1932x1923px:
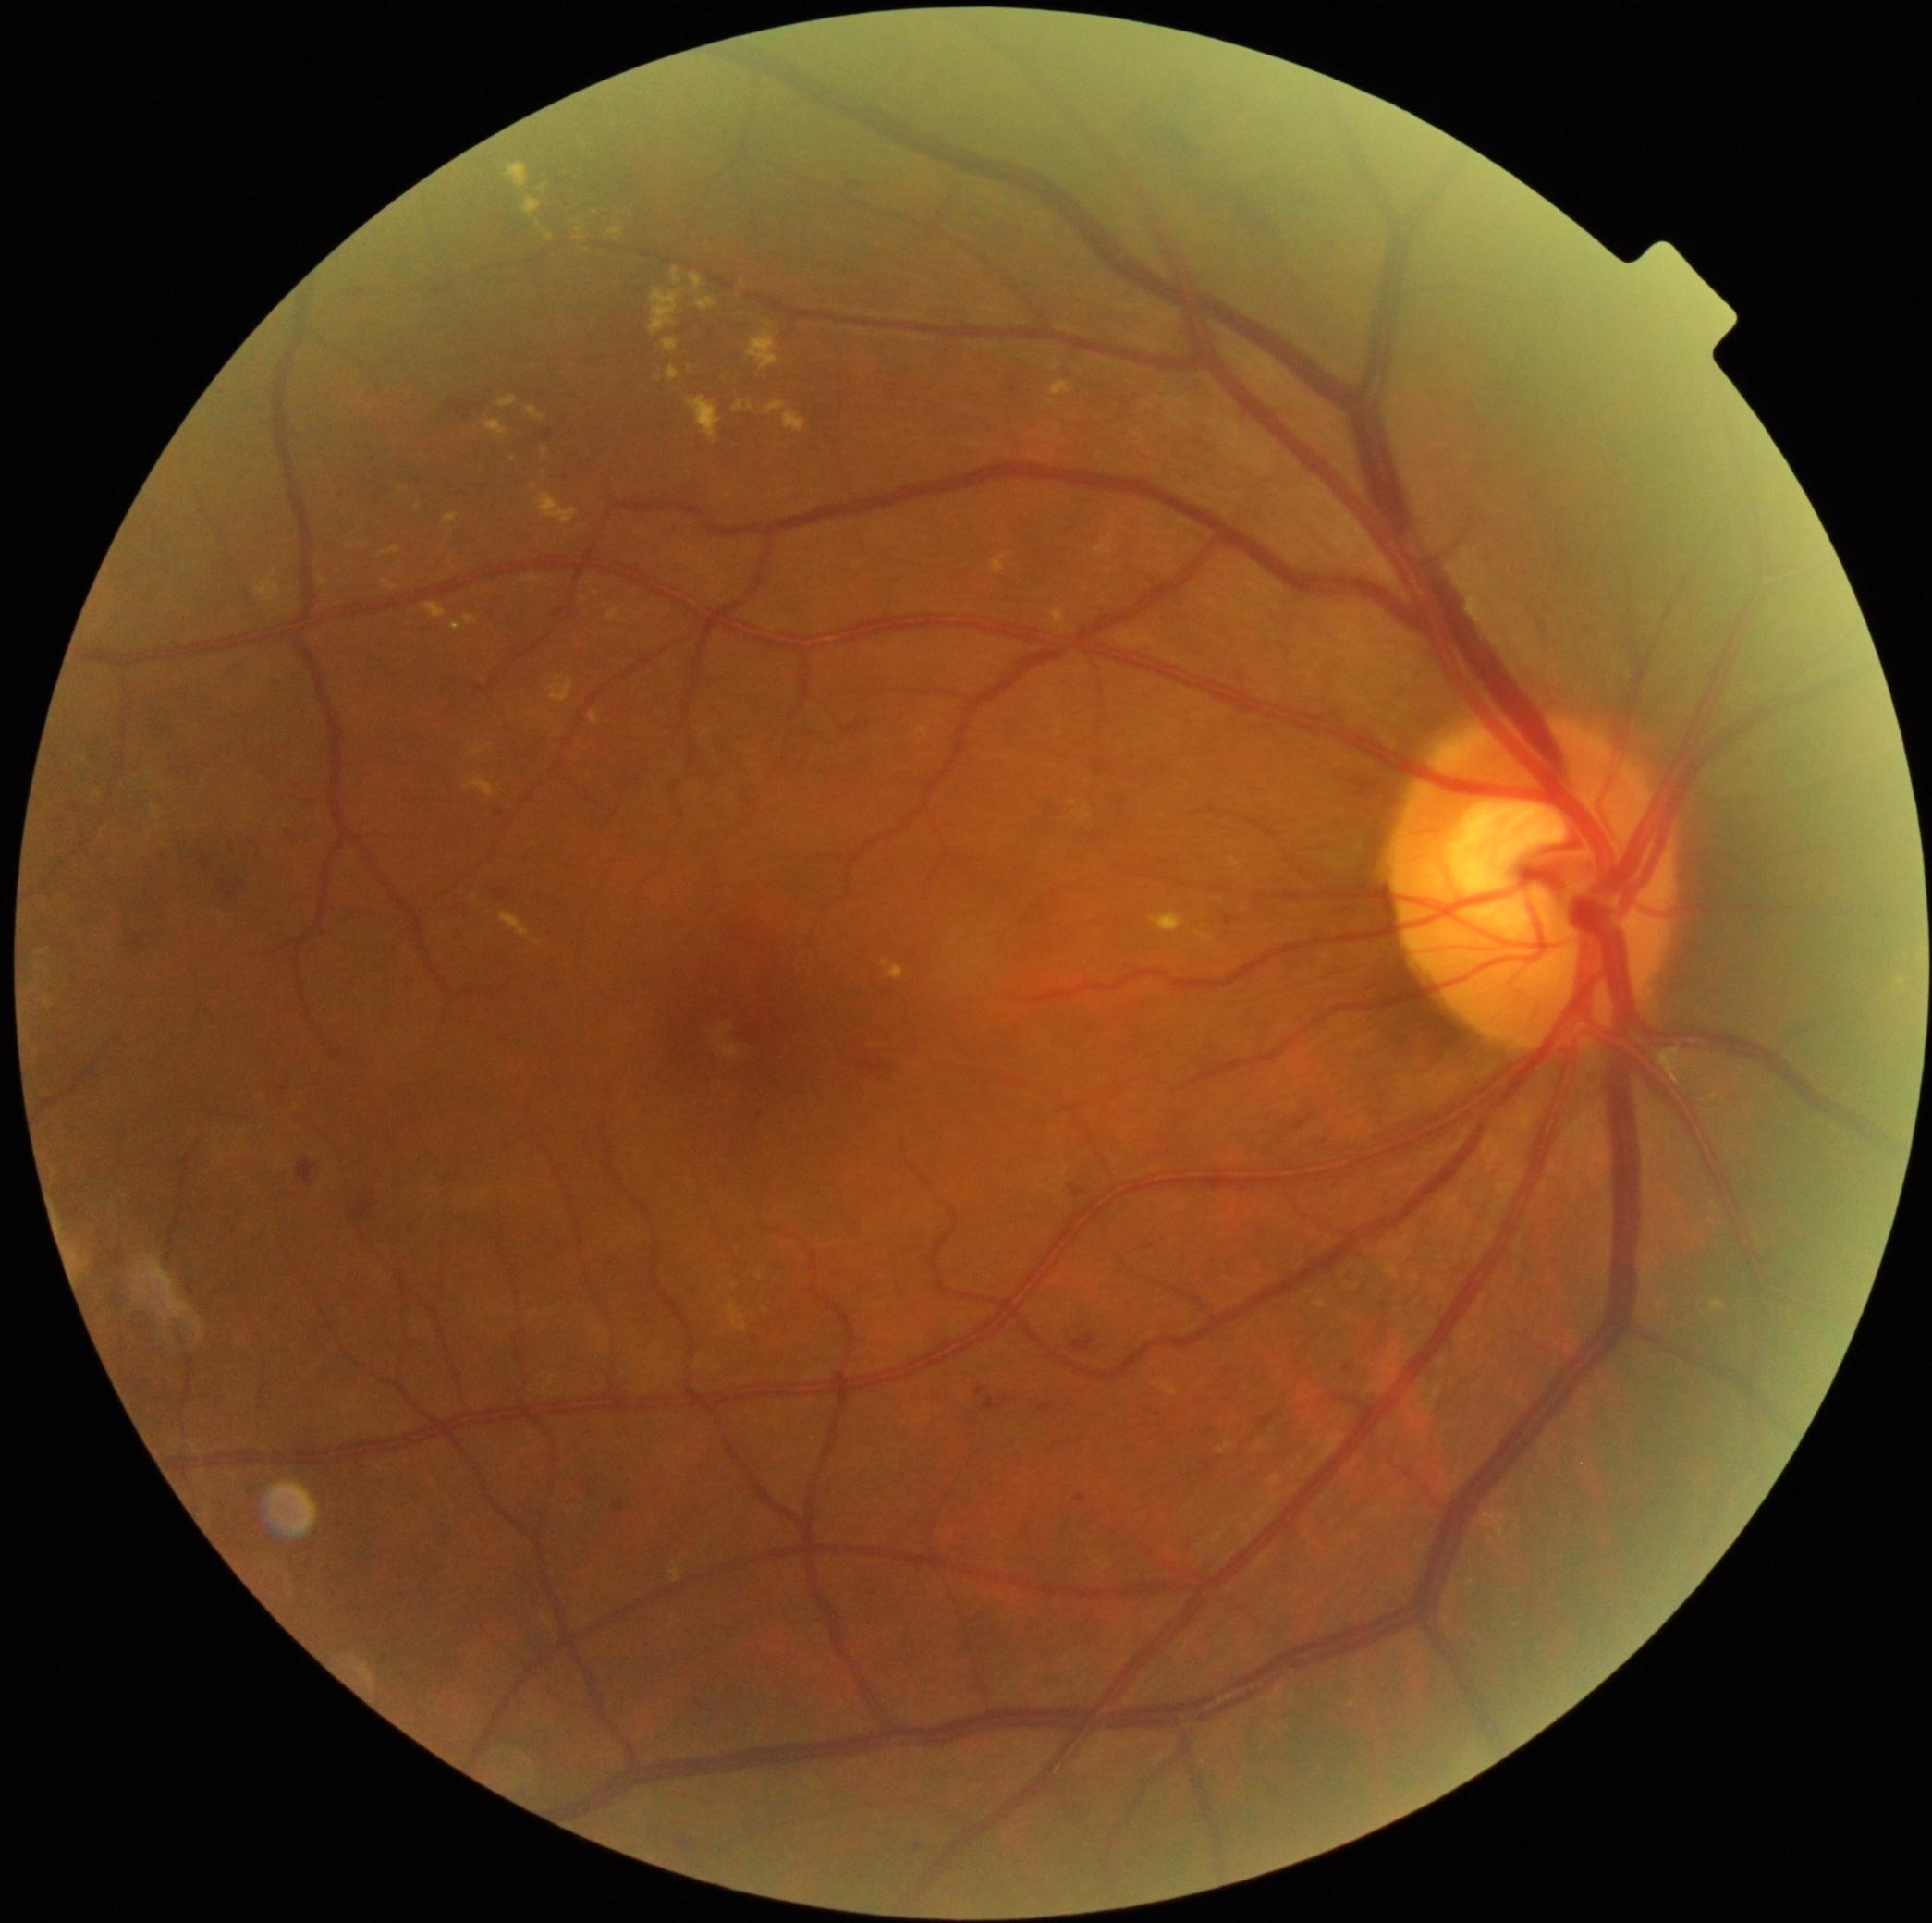
Diabetic retinopathy (DR) is moderate non-proliferative diabetic retinopathy (grade 2) — more than just microaneurysms but less than severe NPDR
Representative lesions:
hard exudates (EXs) (more not shown): box(728, 1304, 748, 1333), box(500, 913, 532, 940), box(991, 553, 1011, 573), box(1075, 806, 1092, 819), box(523, 577, 542, 583), box(920, 729, 929, 738), box(383, 579, 399, 593), box(695, 299, 717, 312), box(534, 942, 542, 948), box(547, 235, 555, 242), box(445, 514, 459, 525), box(525, 407, 545, 420)
Small EXs near pt(583, 147), pt(151, 834), pt(578, 229), pt(735, 1288), pt(1074, 805)